848 x 848 pixels. Davis DR grading. Camera: NIDEK AFC-230 — 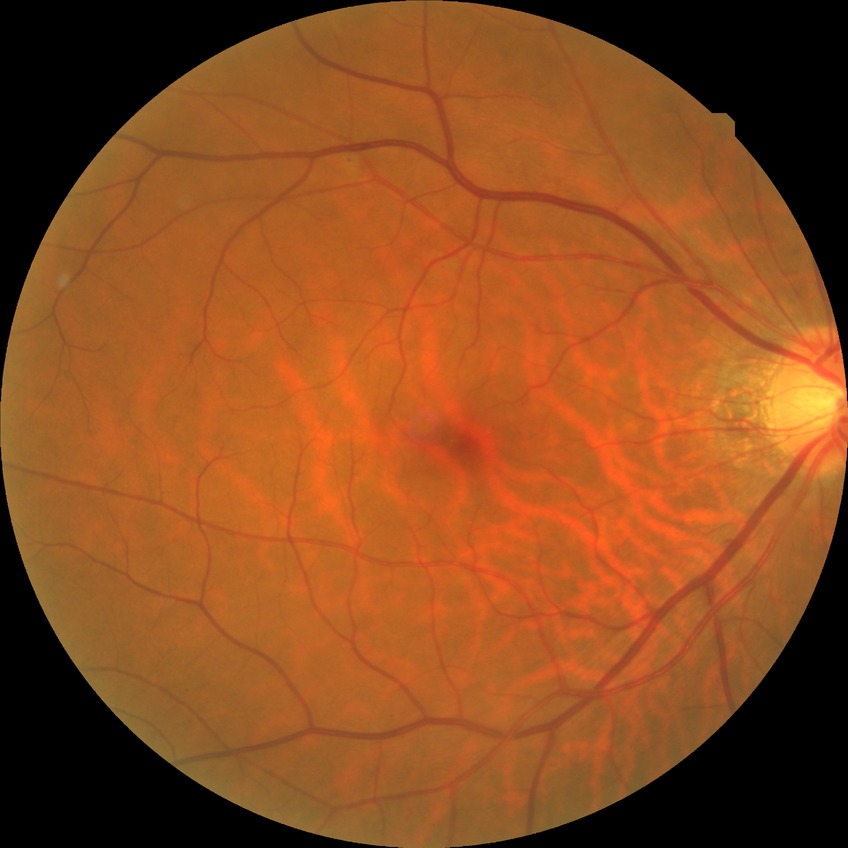

Diabetic retinopathy grade: no diabetic retinopathy.